848 x 848 pixels, retinal fundus photograph: 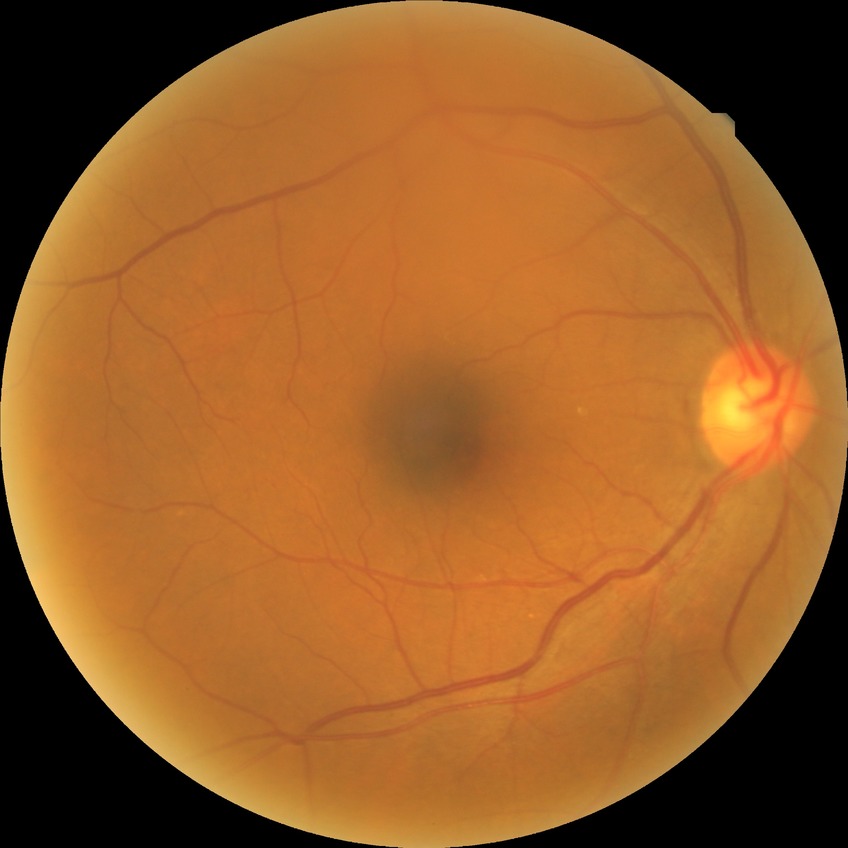
diabetic retinopathy (DR): simple diabetic retinopathy (SDR)